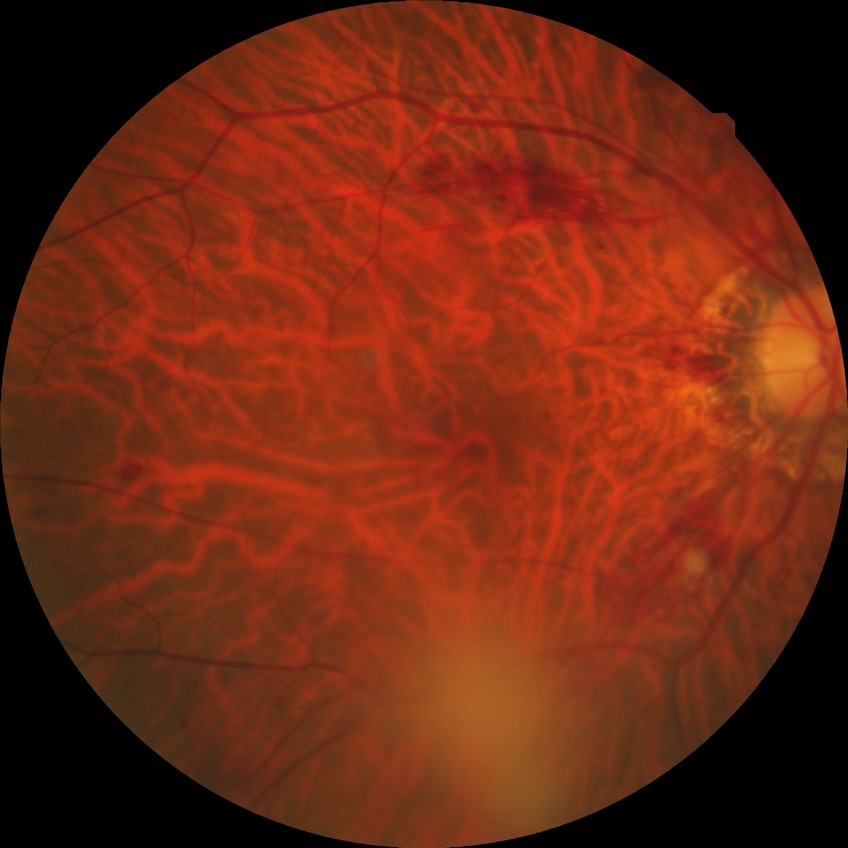
diabetic retinopathy severity=pre-proliferative diabetic retinopathy.